Color fundus image; no pharmacologic dilation — 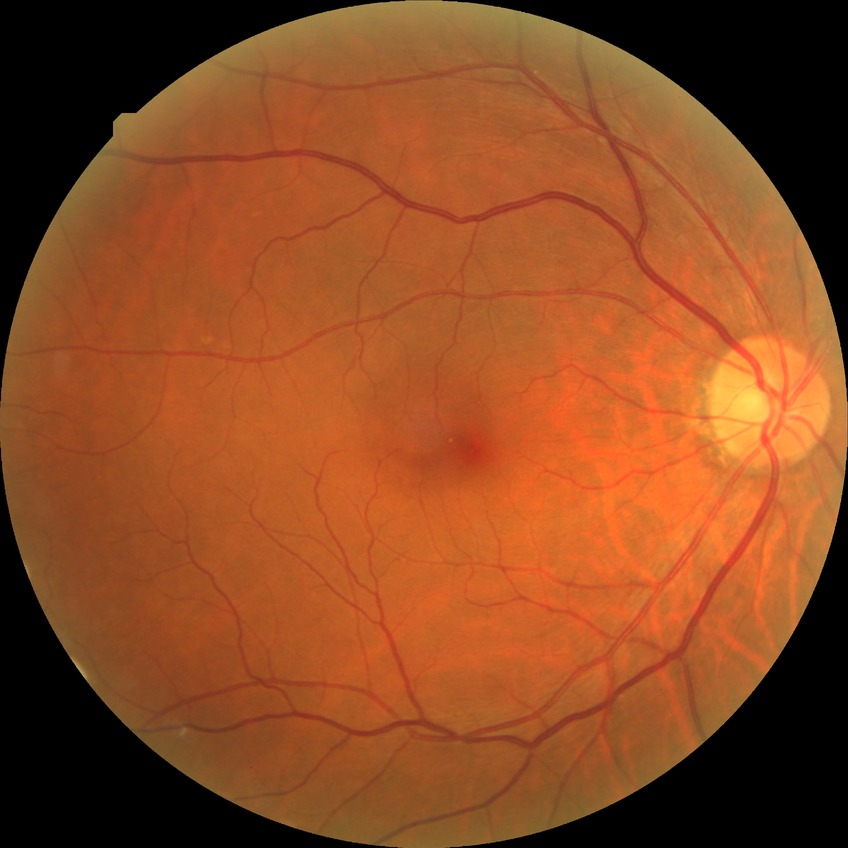
Diabetic retinopathy (DR) is no diabetic retinopathy (NDR).